Diabetic retinopathy graded by the modified Davis classification; 45° field of view; nonmydriatic
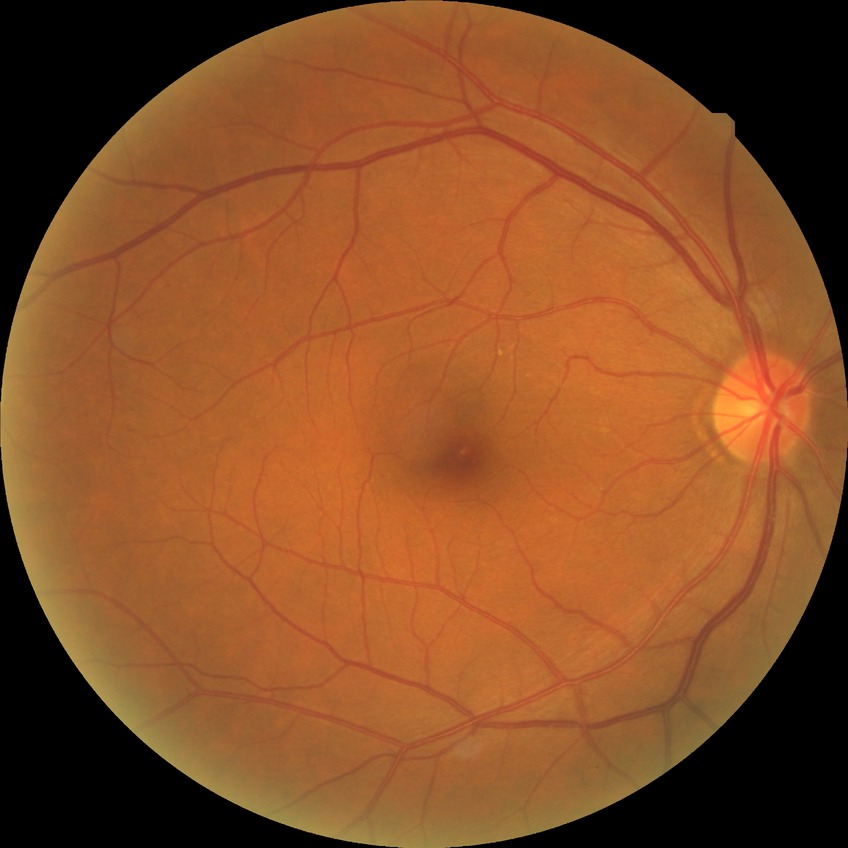
Diabetic retinopathy (DR) is NDR (no diabetic retinopathy).